Wide-field fundus image from infant ROP screening:
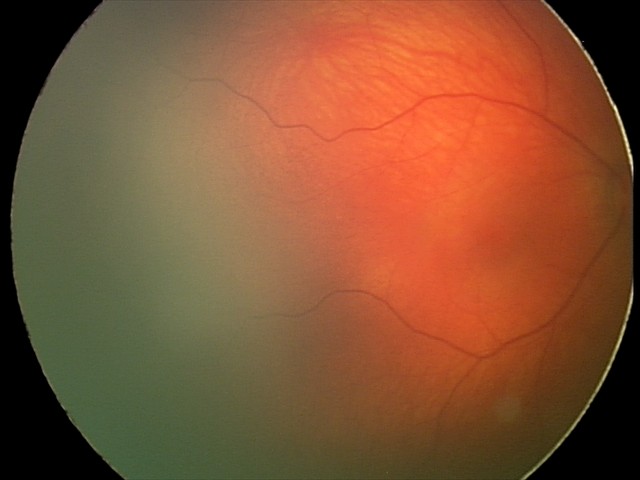

Examination diagnosed as retinal hemorrhages.